Color fundus image.
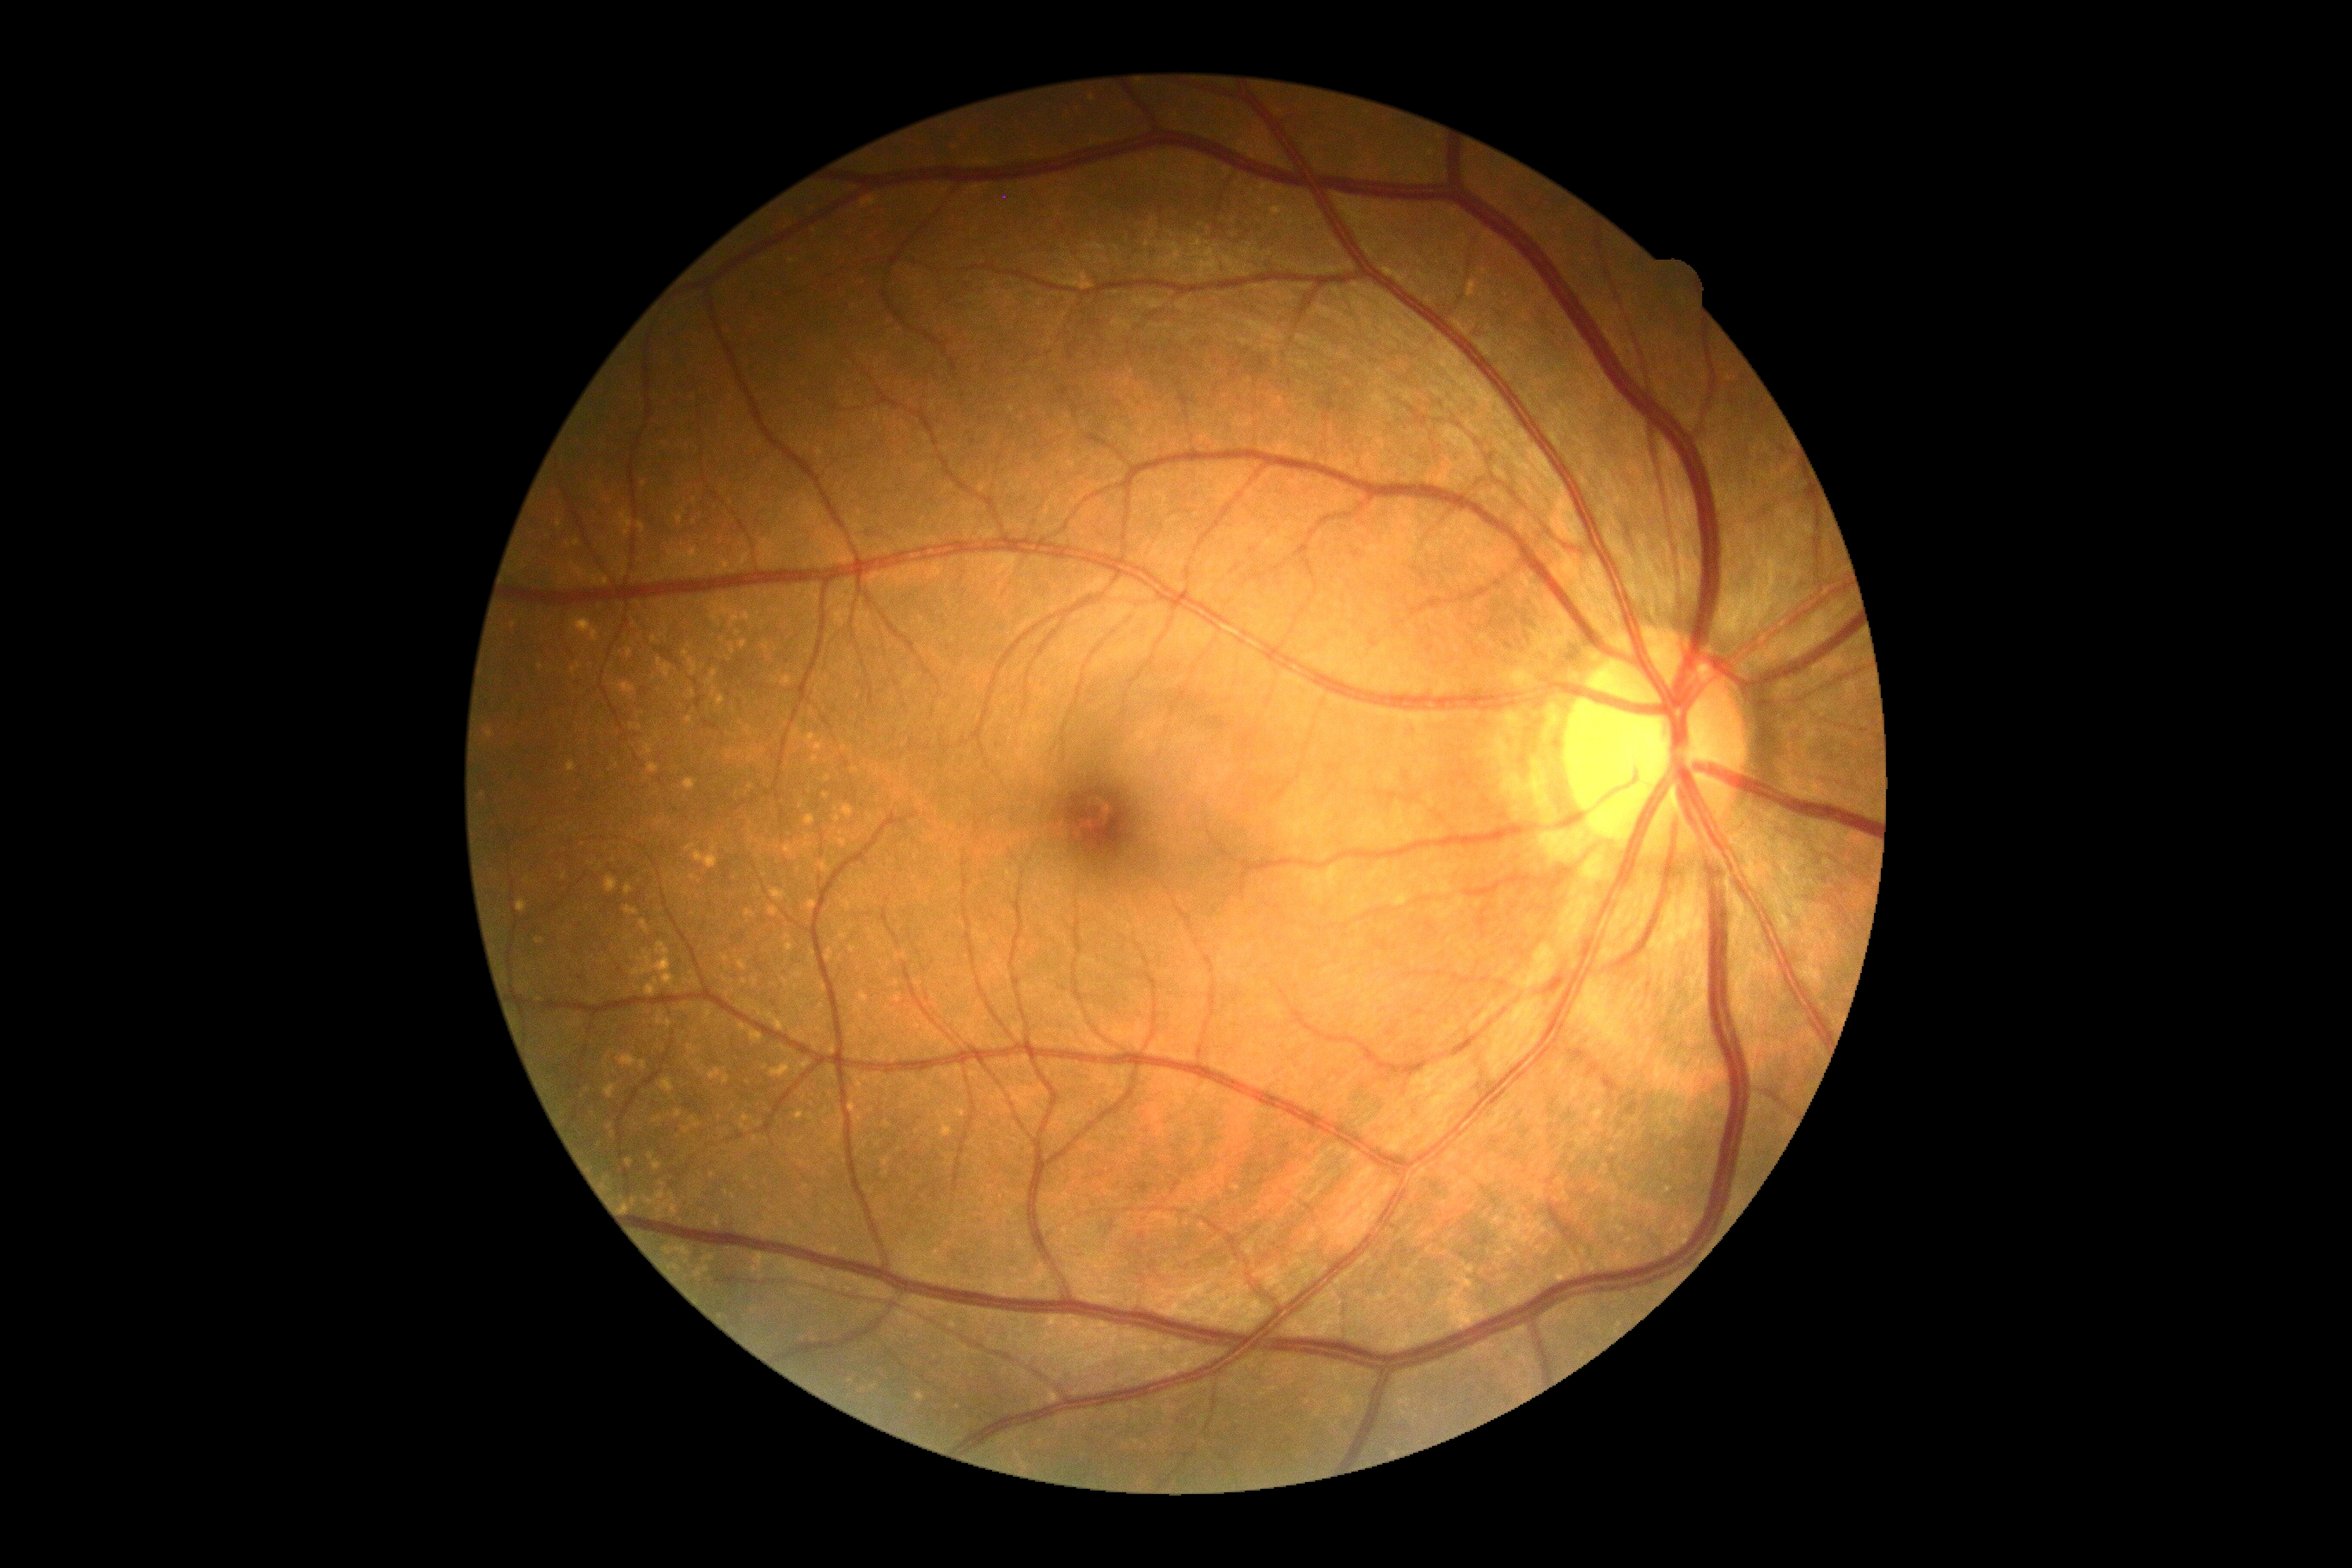

diabetic retinopathy (DR) = 0.